Diabetic retinopathy graded by the modified Davis classification — 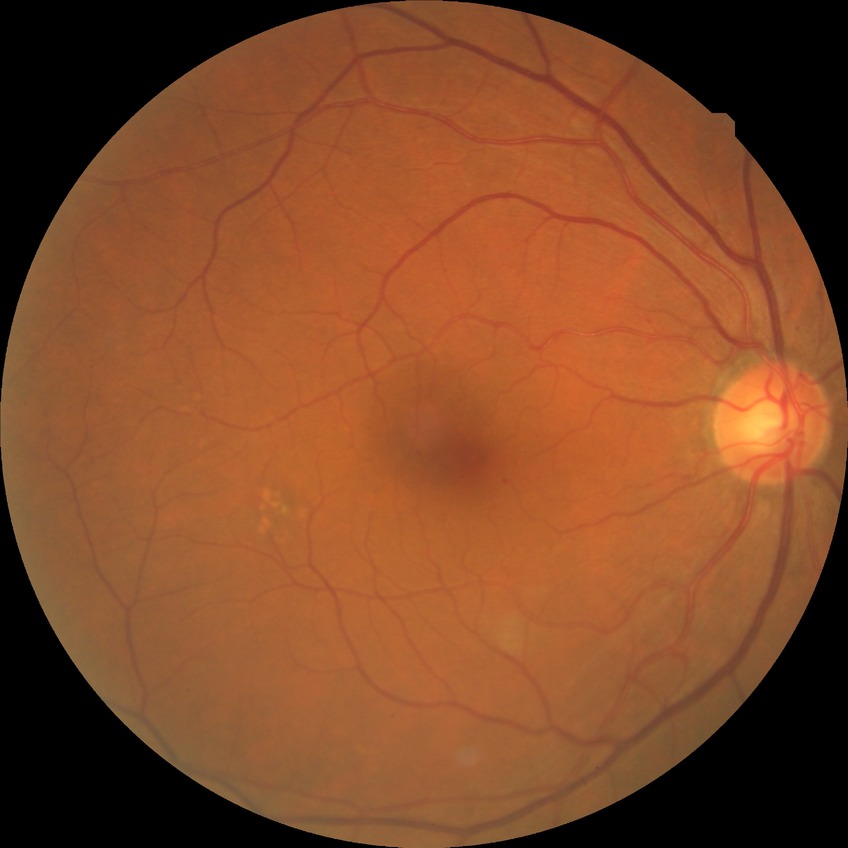

{
  "davis_grade": "simple diabetic retinopathy"
}